Color fundus photograph; image size 2352x1568:
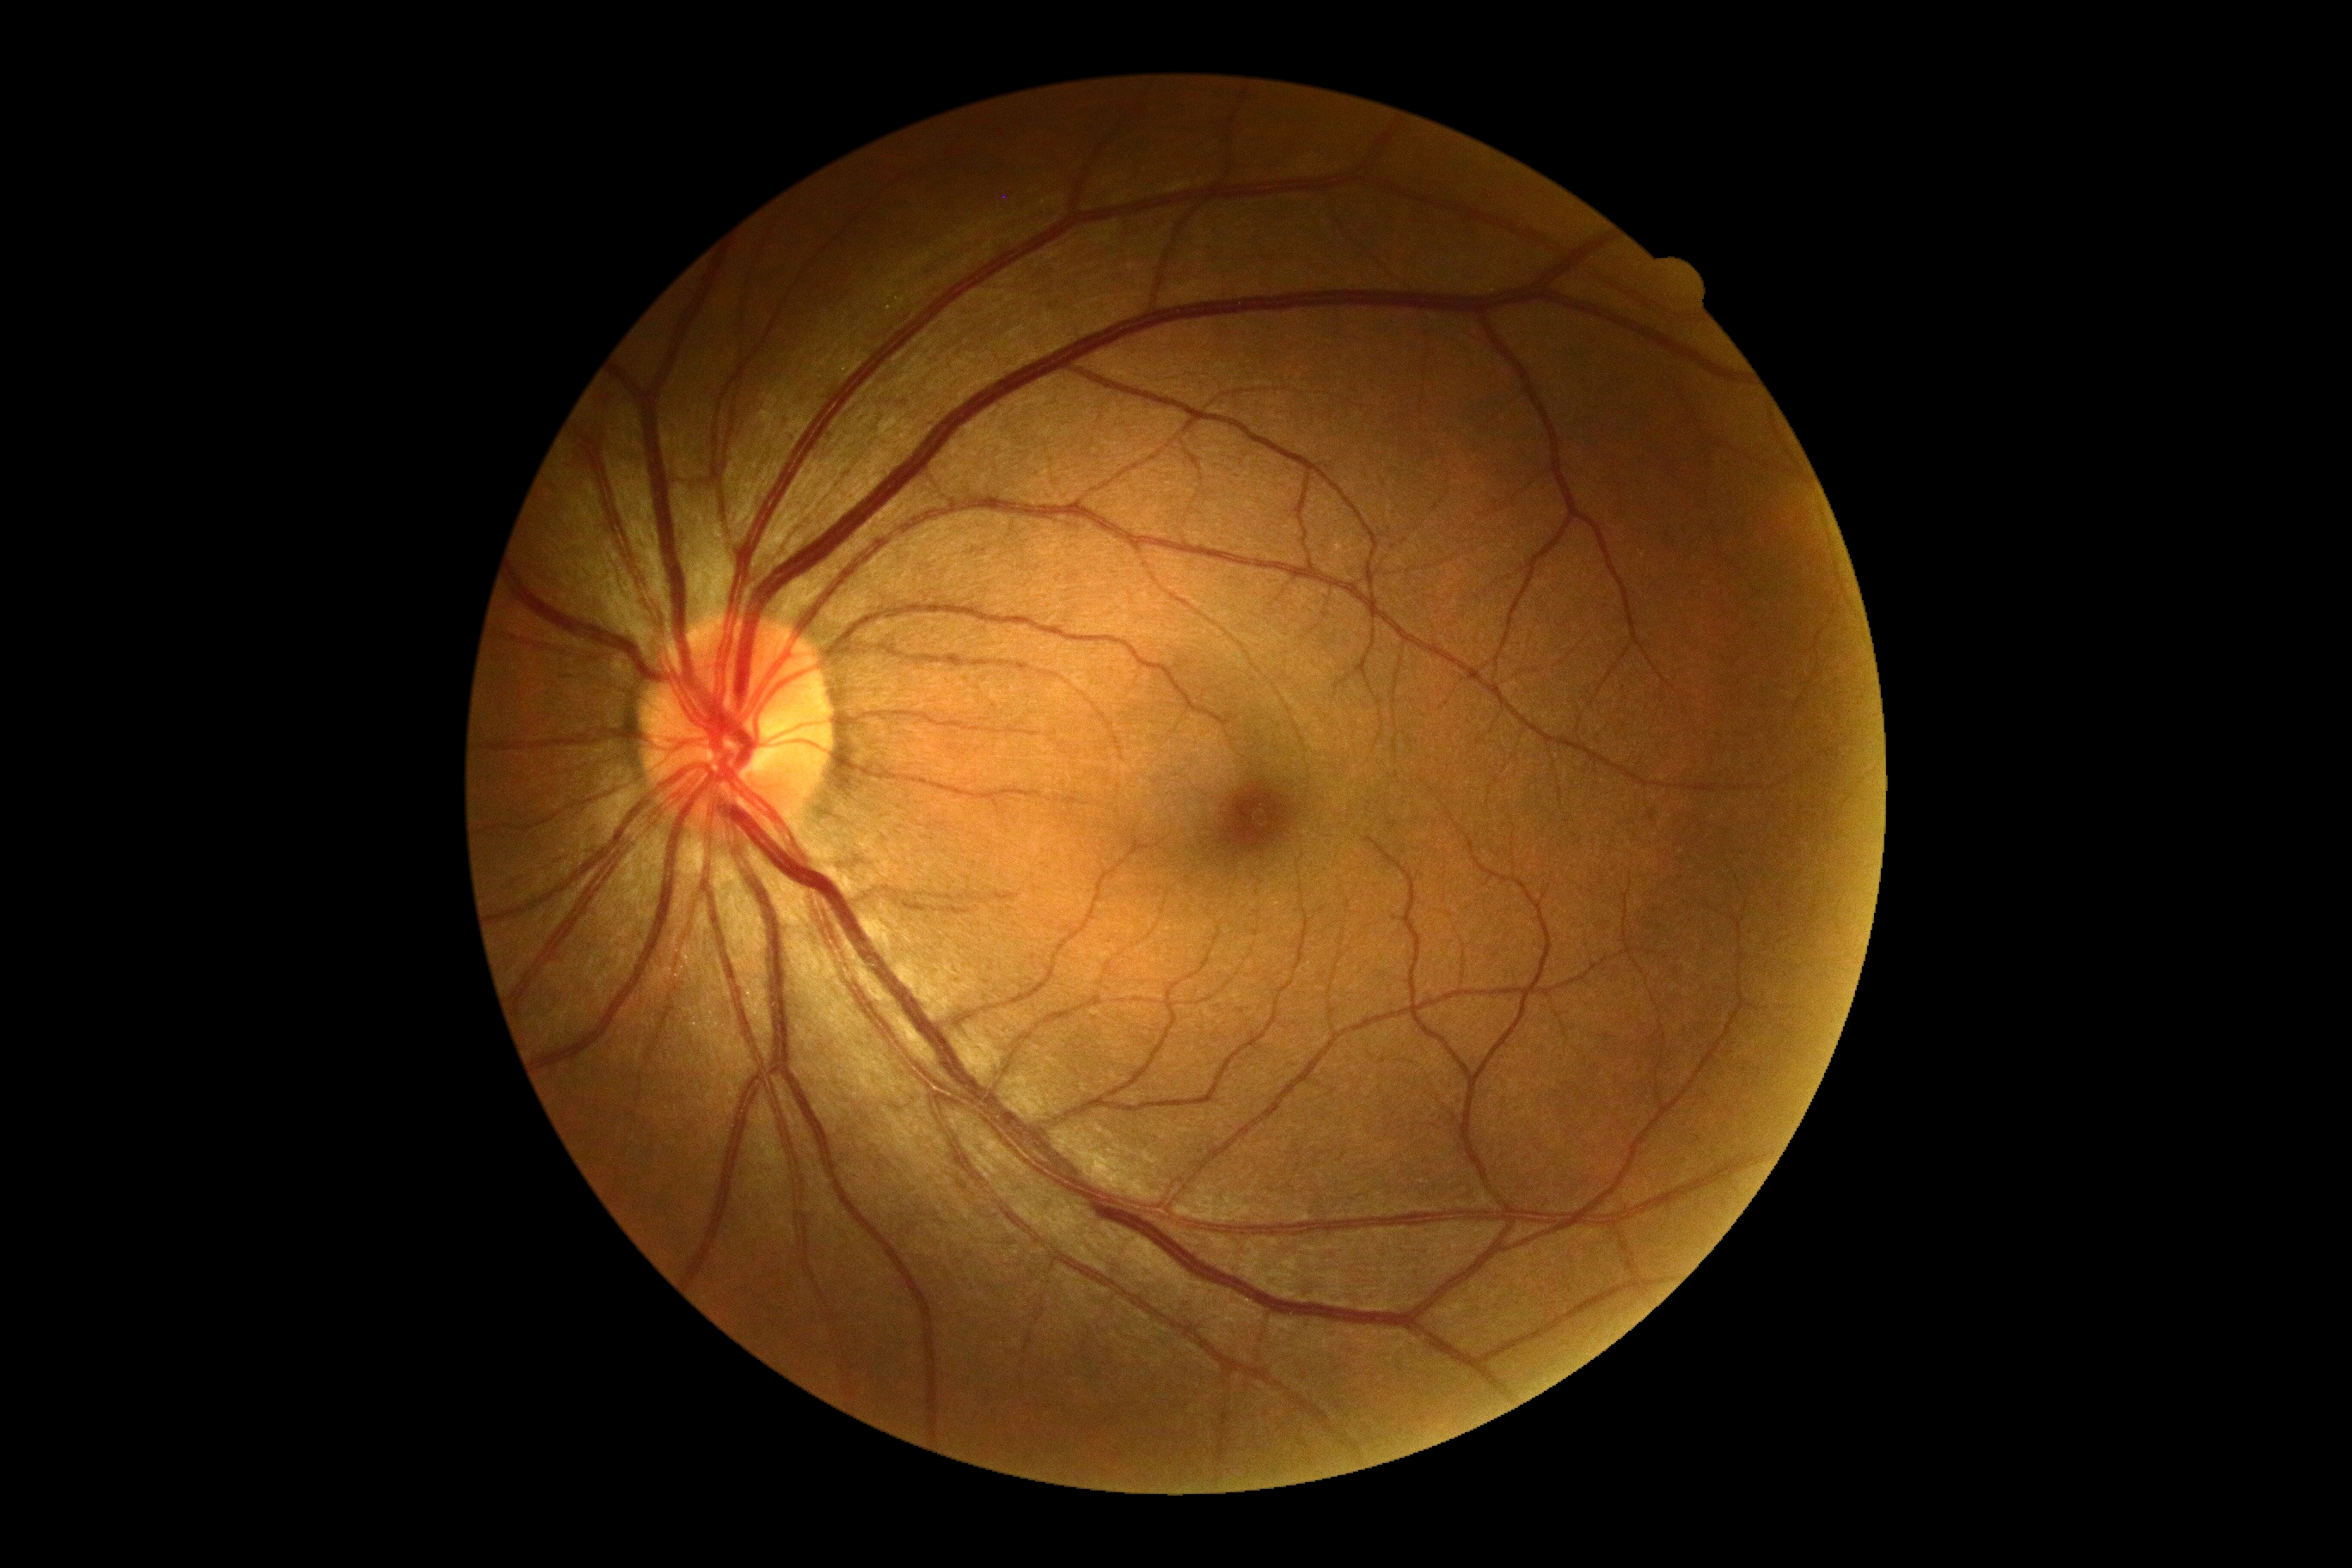 DR severity: grade 0 (no apparent retinopathy)
DR impression: no apparent DR